Retinal fundus photograph. 45° field of view — 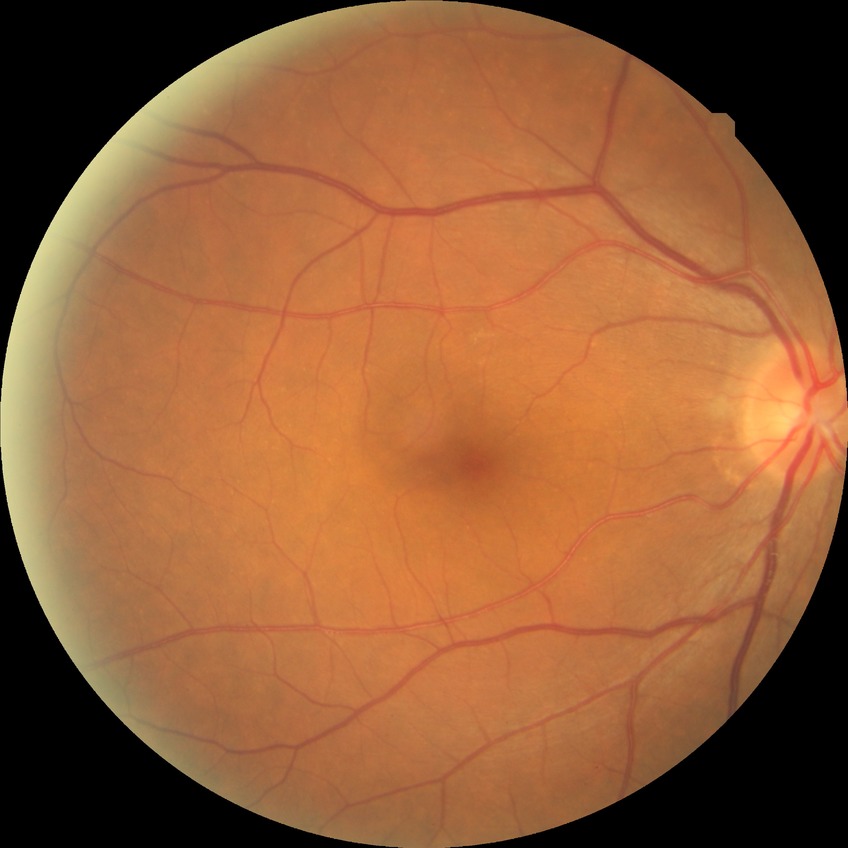 Modified Davis grade is NDR.